1240 x 1240 pixels. Wide-field fundus photograph of an infant. Captured with the Phoenix ICON (100° field of view).
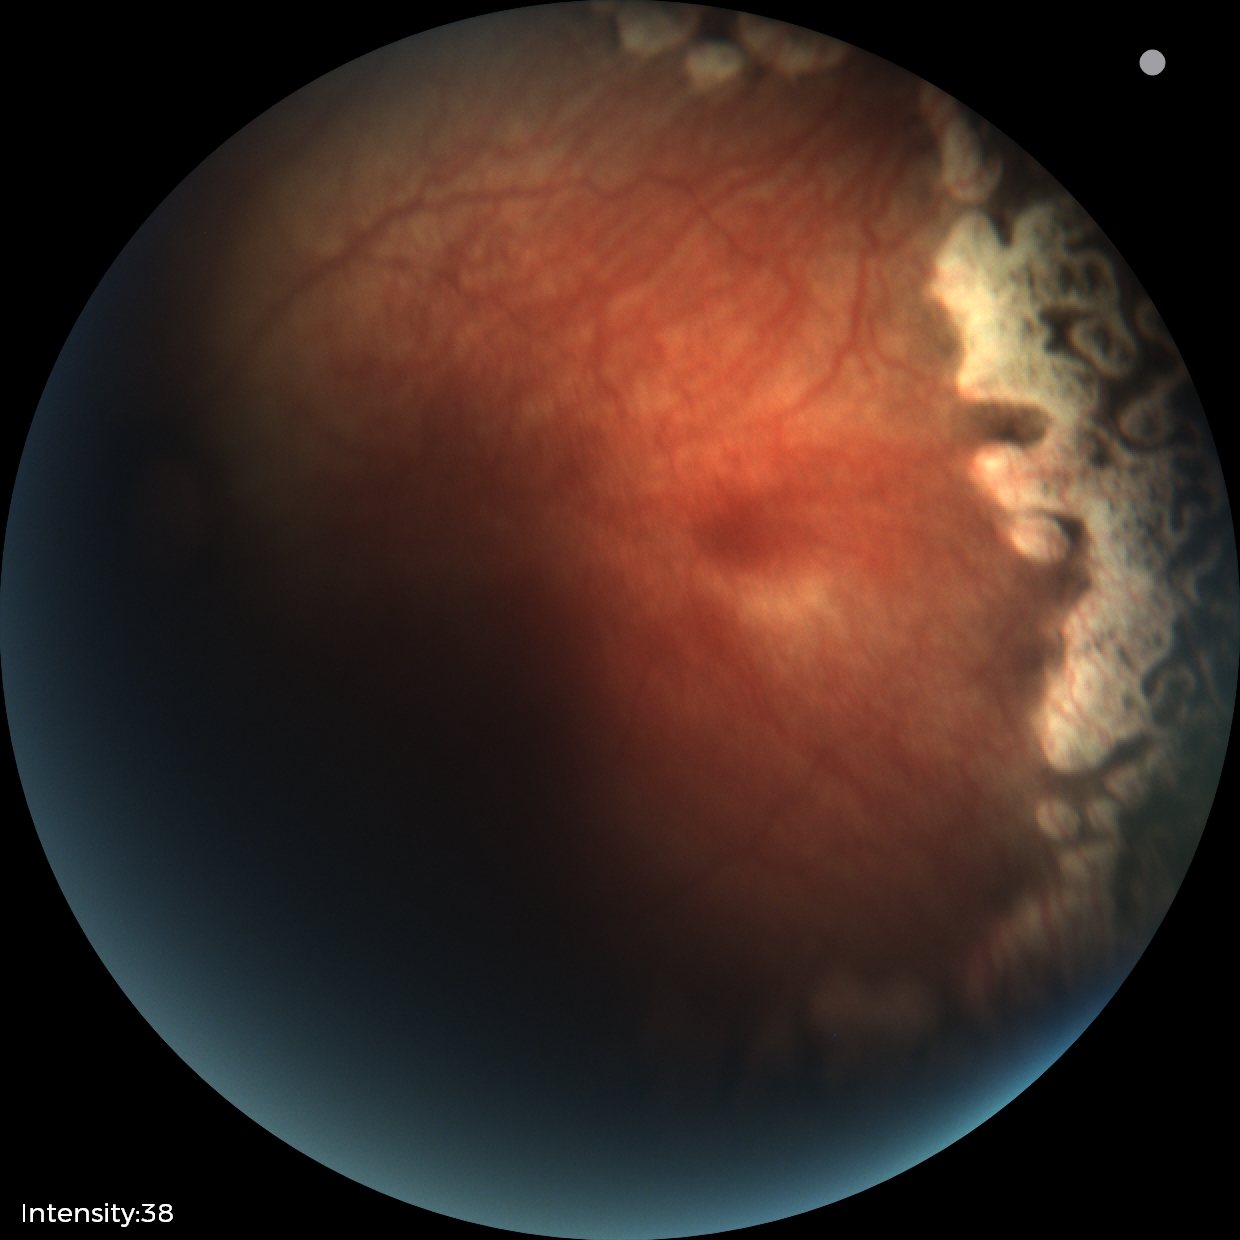 Screening examination consistent with status post ROP.